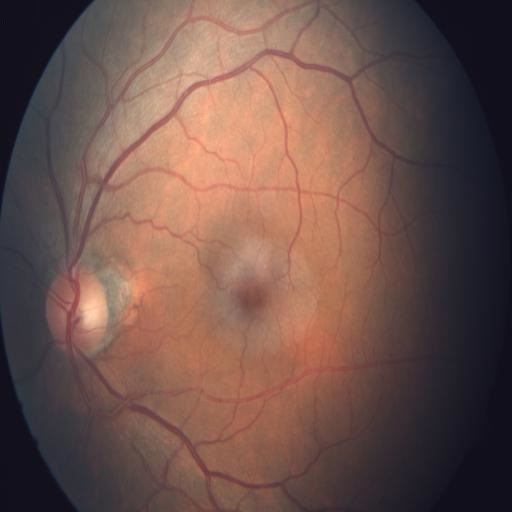

Diagnoses: chorioretinitis (CRS).